Image size 640x480; infant wide-field retinal image: 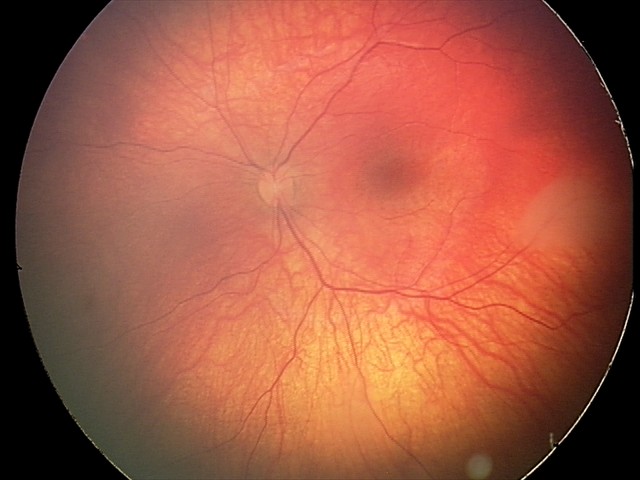

Q: What was the screening finding?
A: retinal astrocytic hamartoma